Camera: NIDEK AFC-230, 45° FOV: 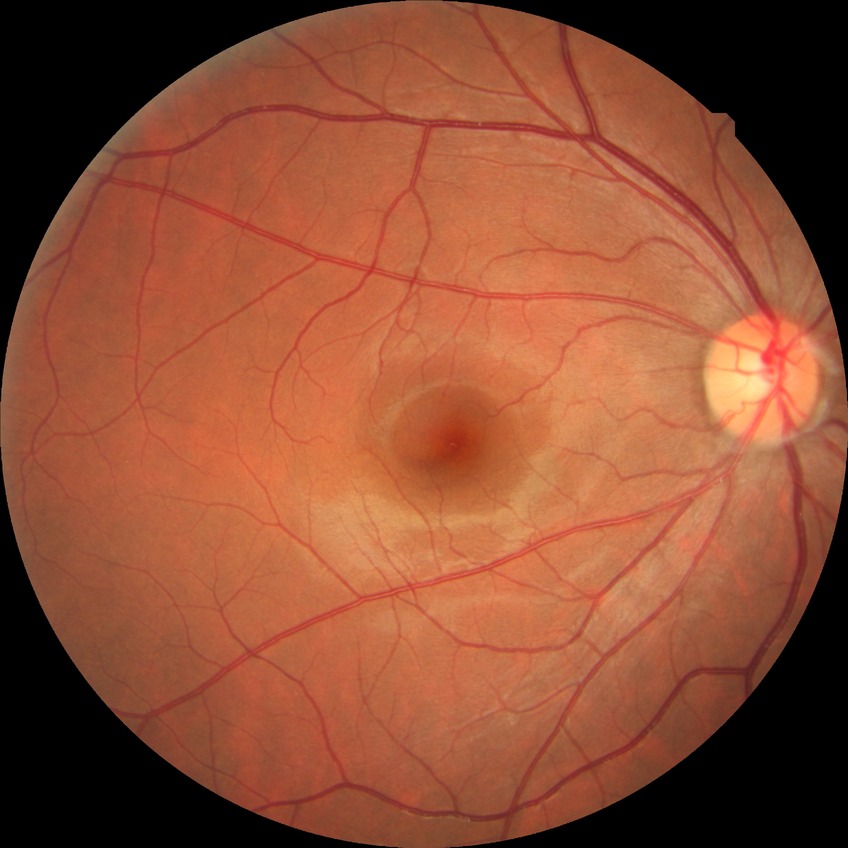
Annotations:
* retinopathy grade — no diabetic retinopathy